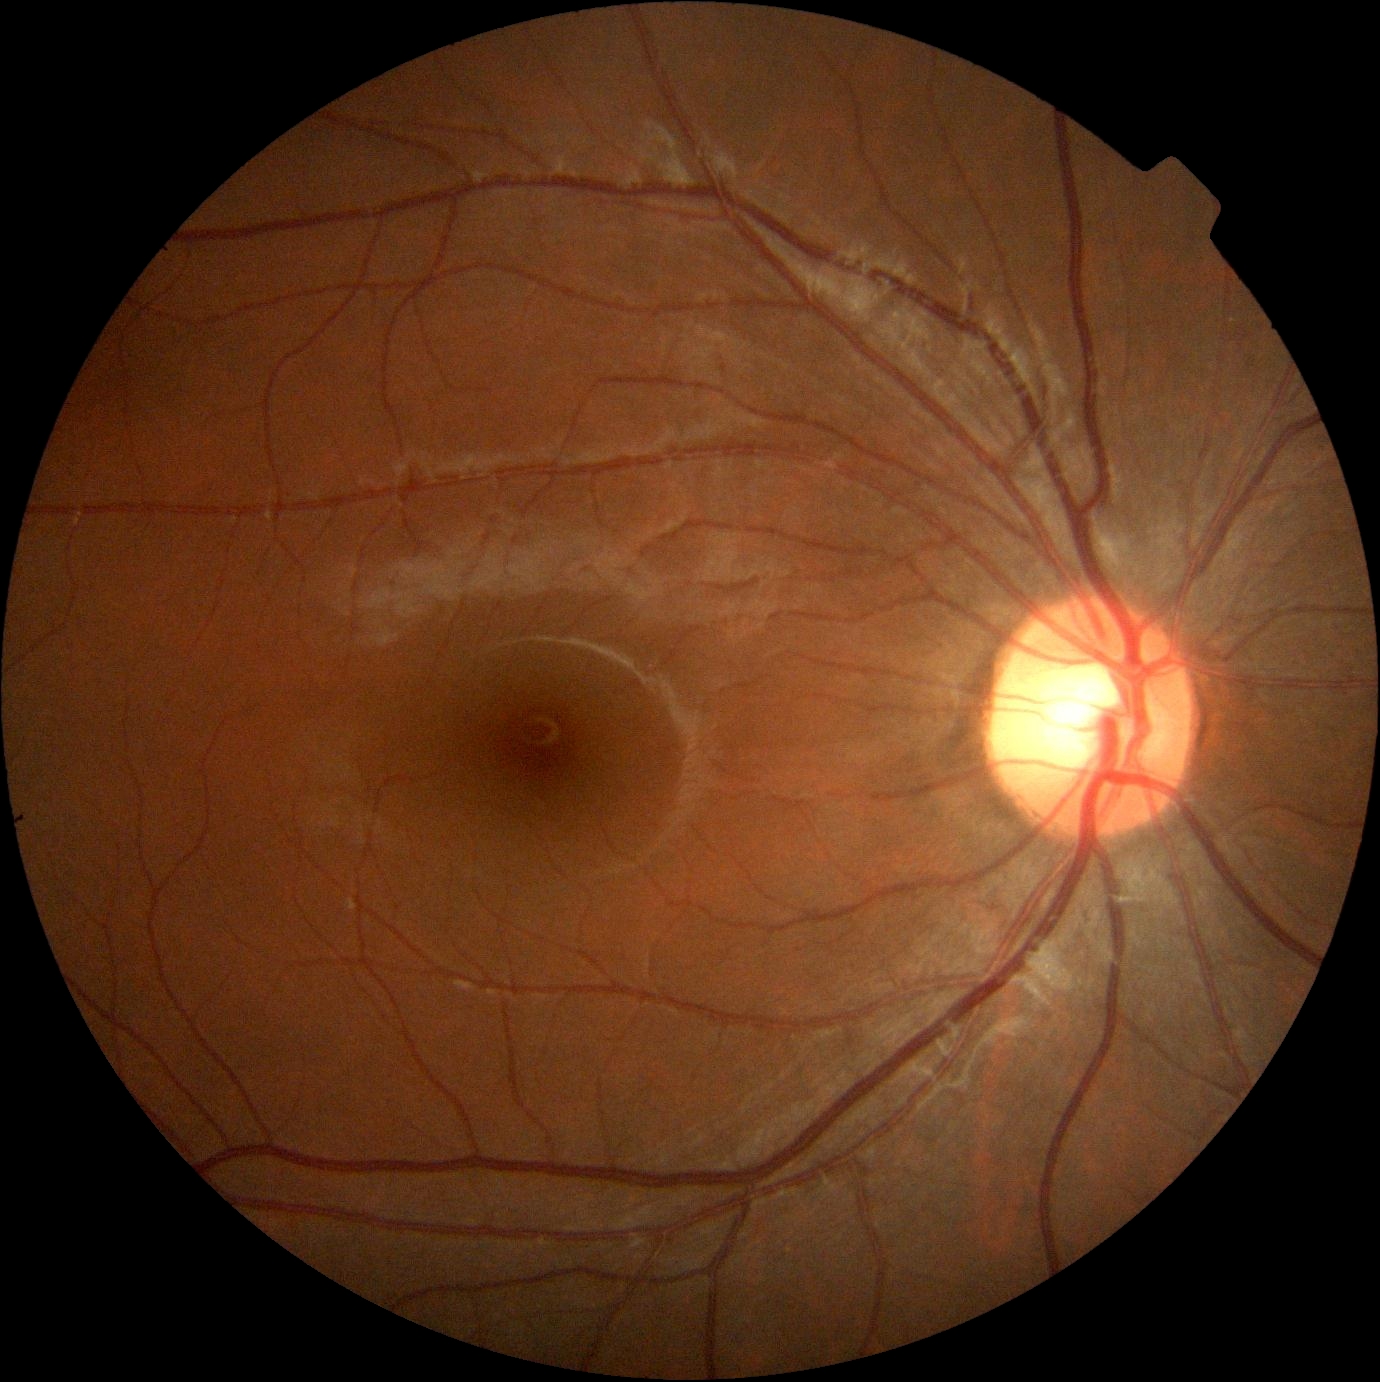

– diabetic retinopathy (DR): 0